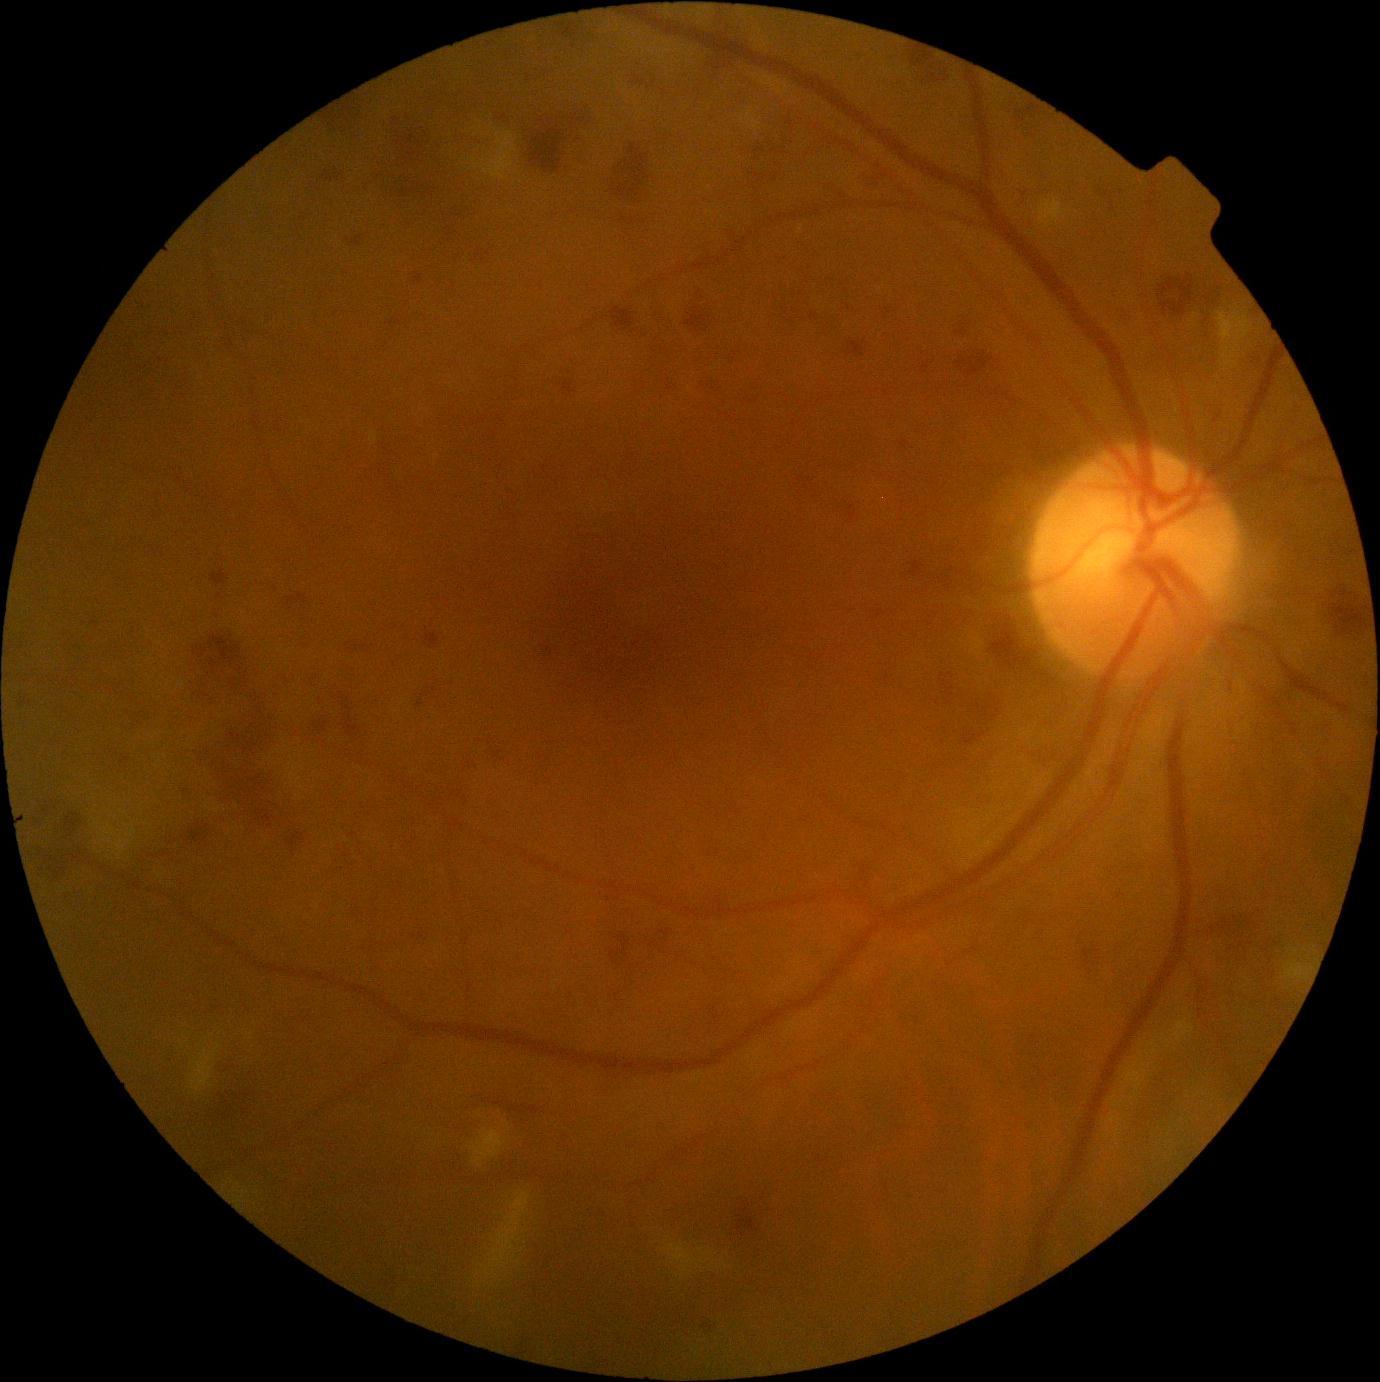   dr_grade: grade 3 — more than 20 intraretinal hemorrhages in each of 4 quadrants, definite venous beading in 2 or more quadrants, or prominent intraretinal microvascular abnormalities in 1 or more quadrants, with no signs of proliferative retinopathy